Wide-field fundus photograph from neonatal ROP screening.
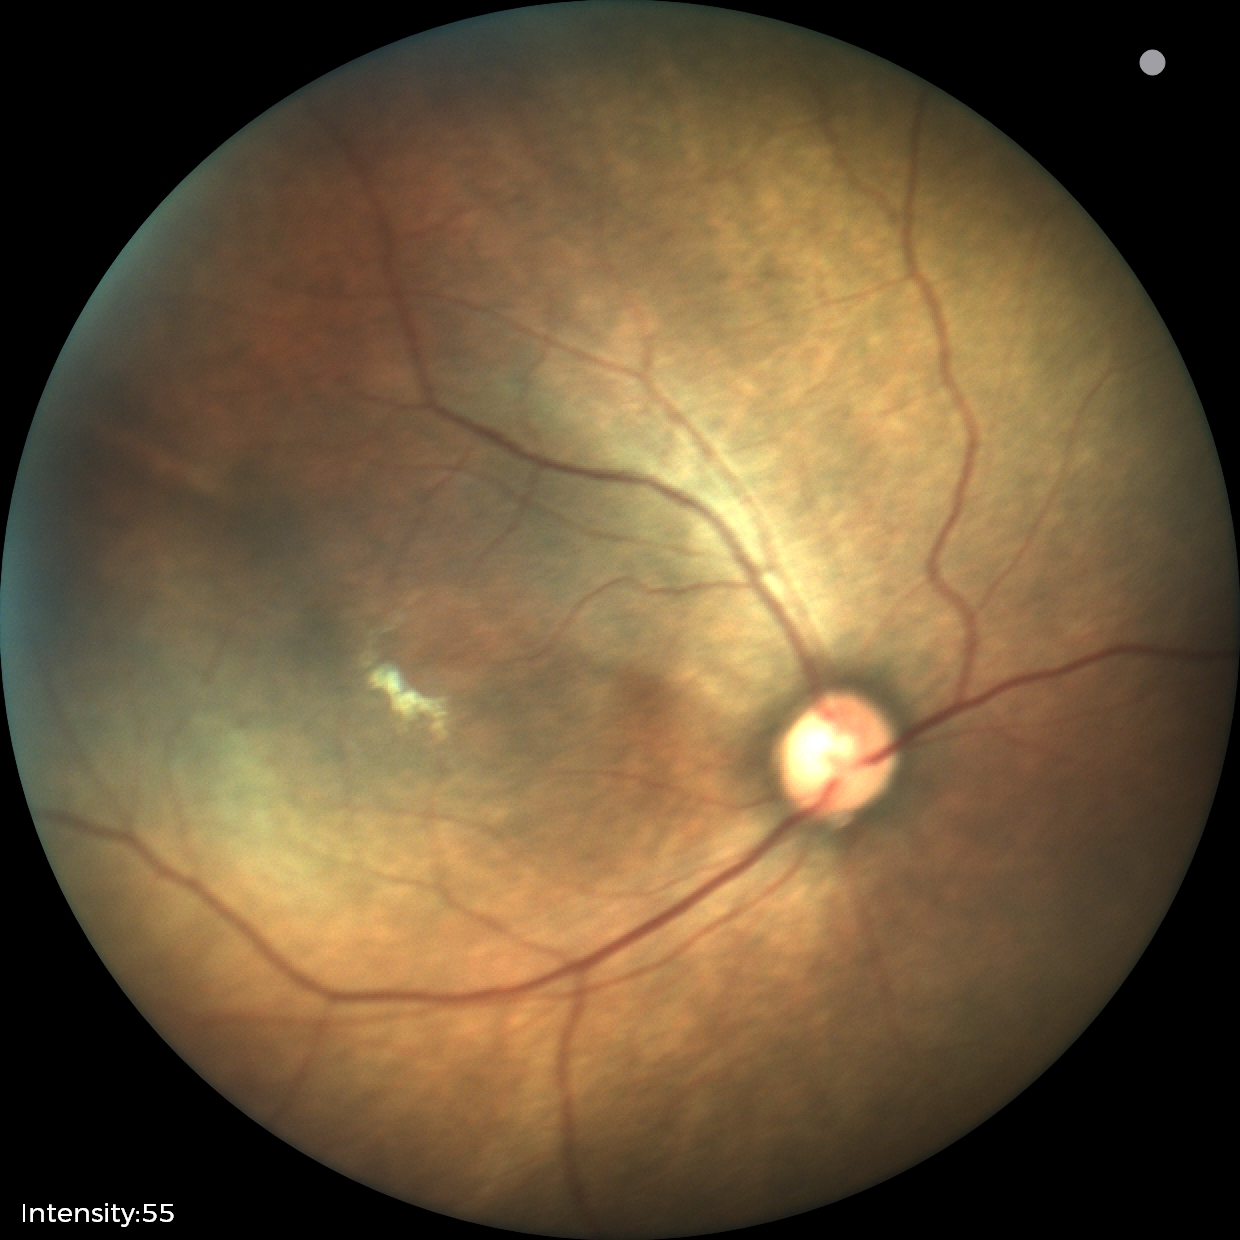

Screening examination consistent with status post retinopathy of prematurity (ROP).